Retinal fundus photograph. 45-degree field of view
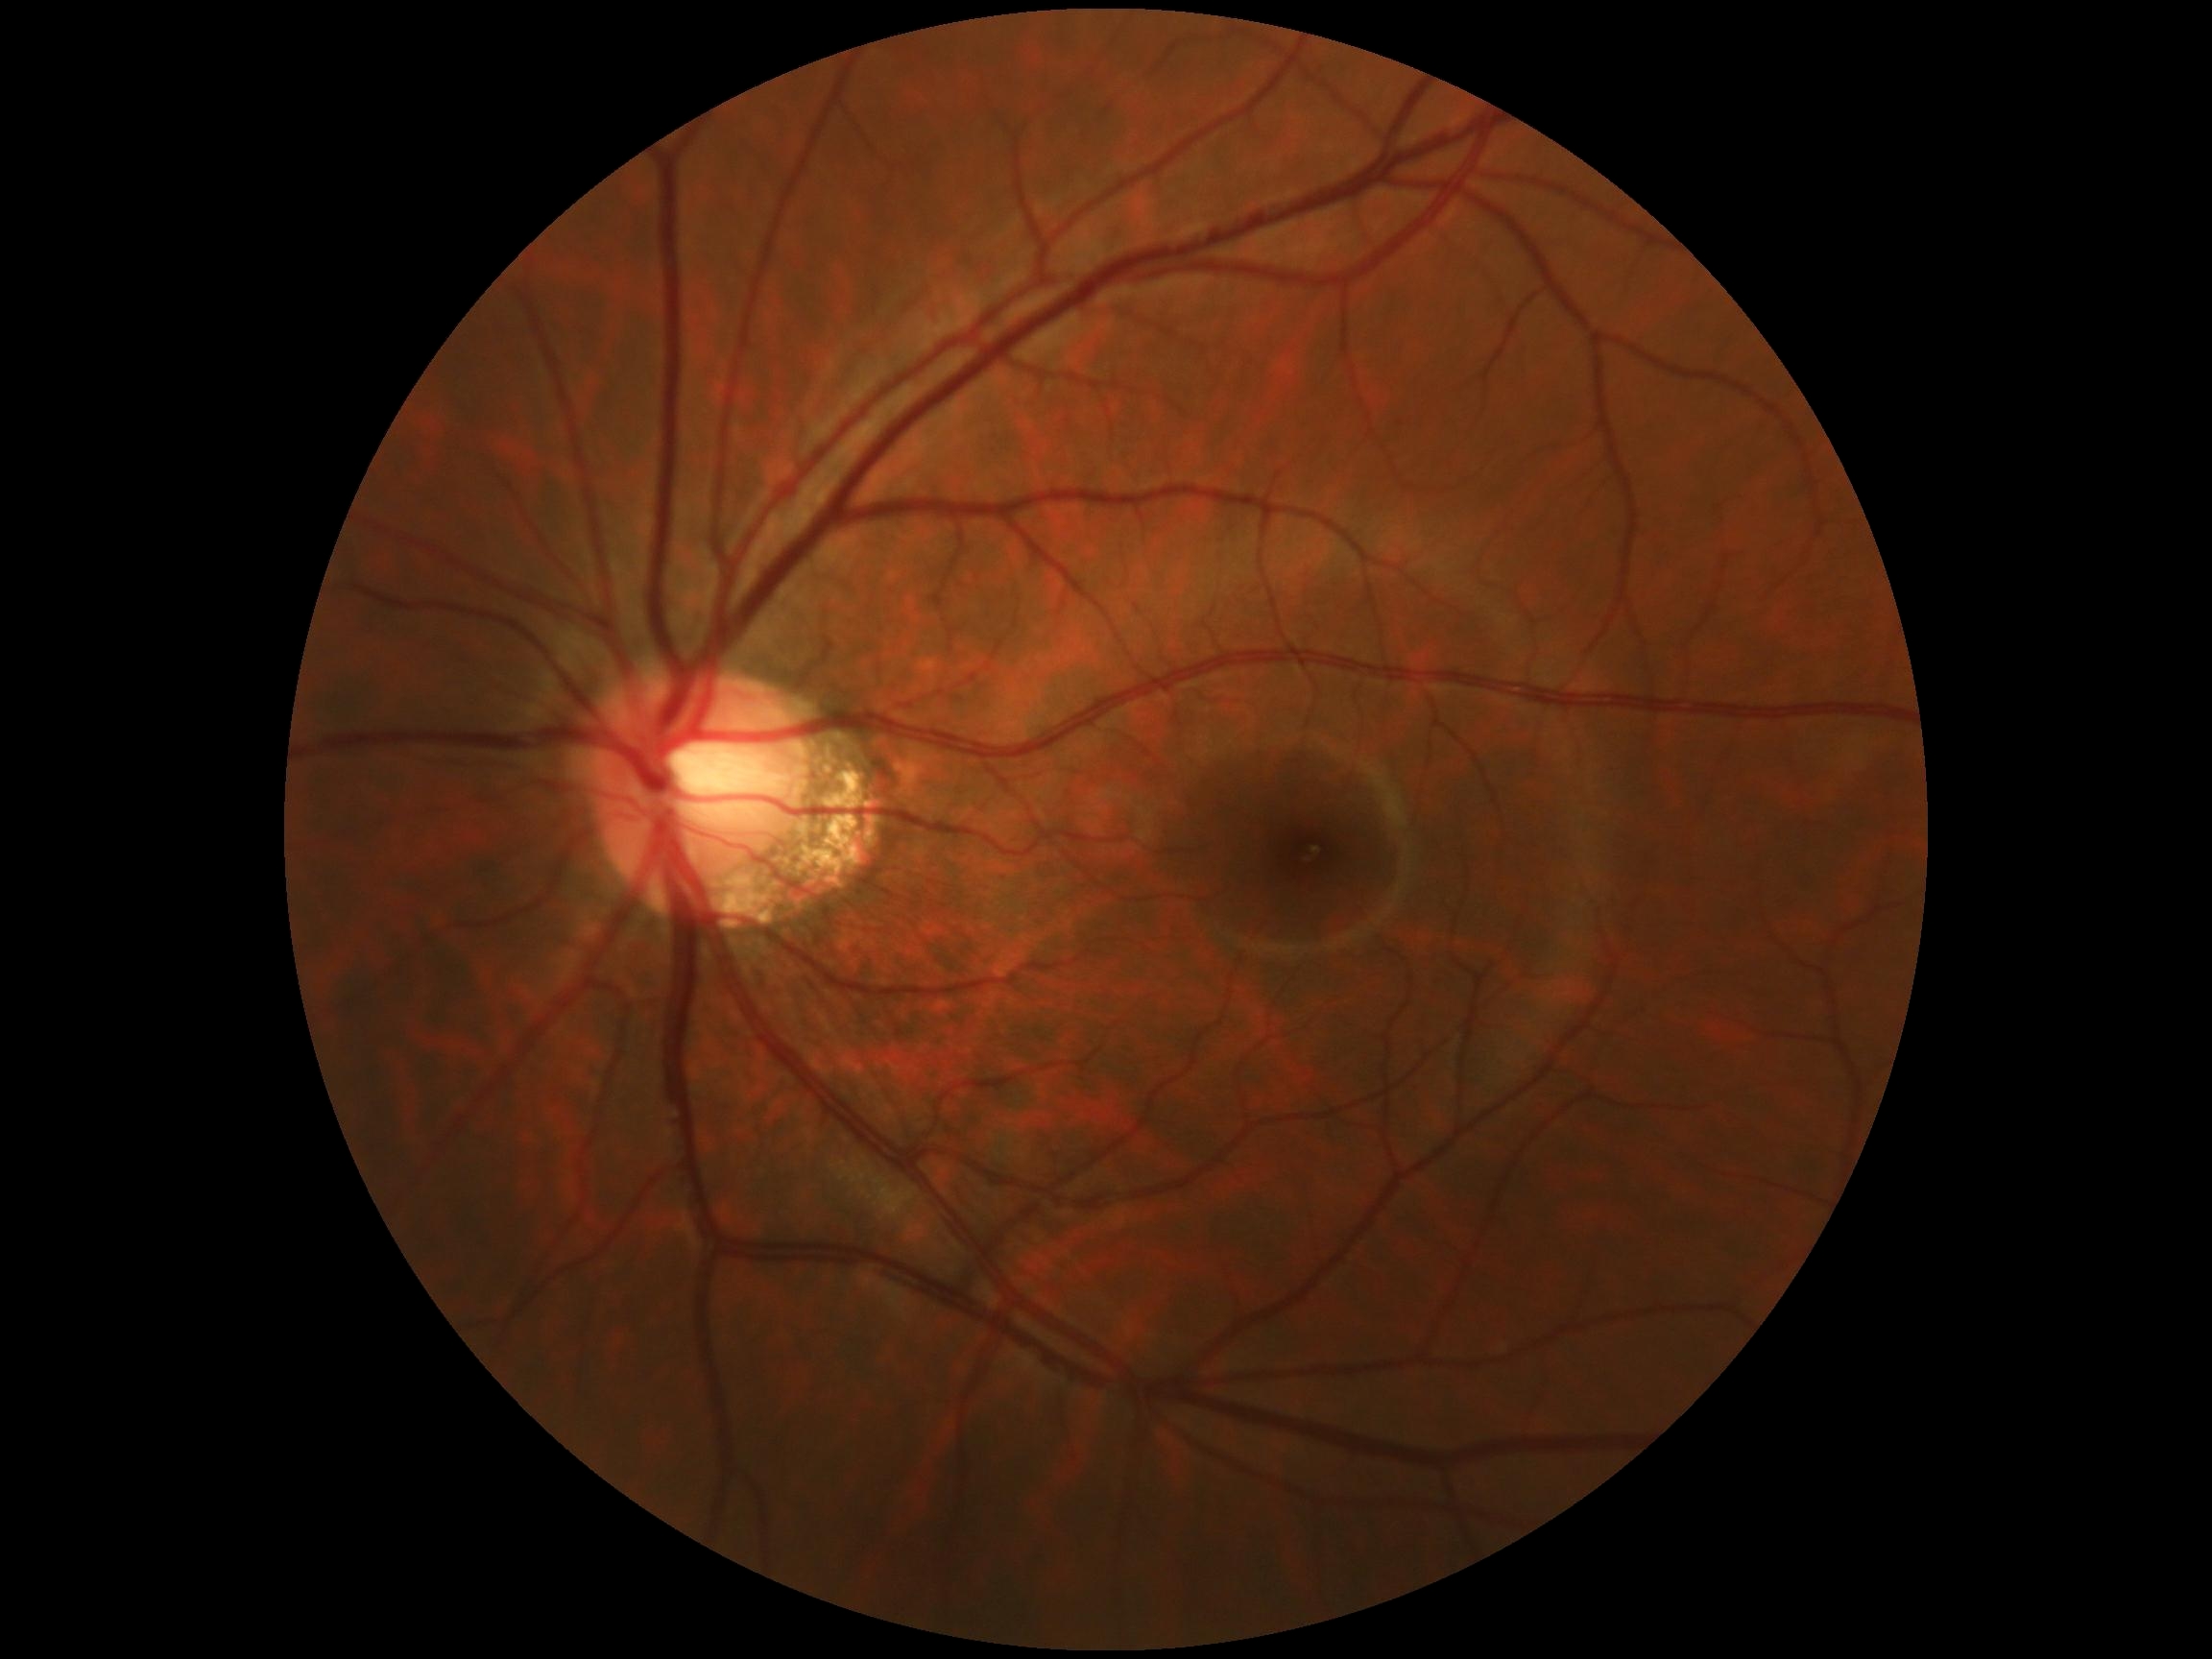 Diabetic retinopathy: 0. No signs of diabetic retinopathy.